Color fundus photograph; without pupil dilation — 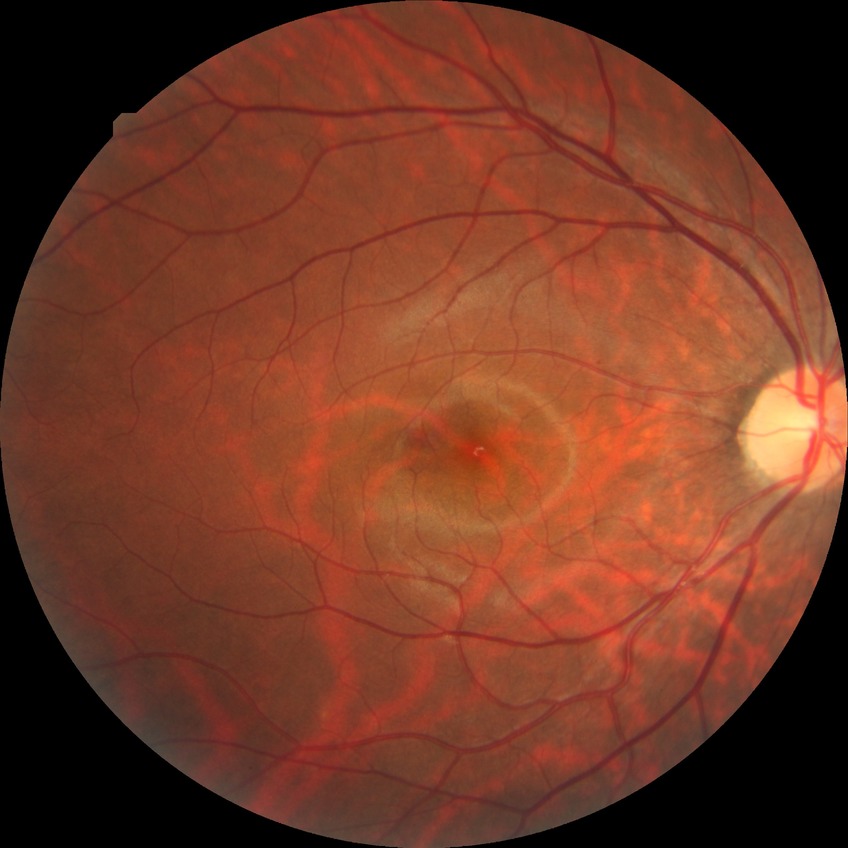

DR grade: NDR.
No signs of diabetic retinopathy.